45° field of view; without pupil dilation: 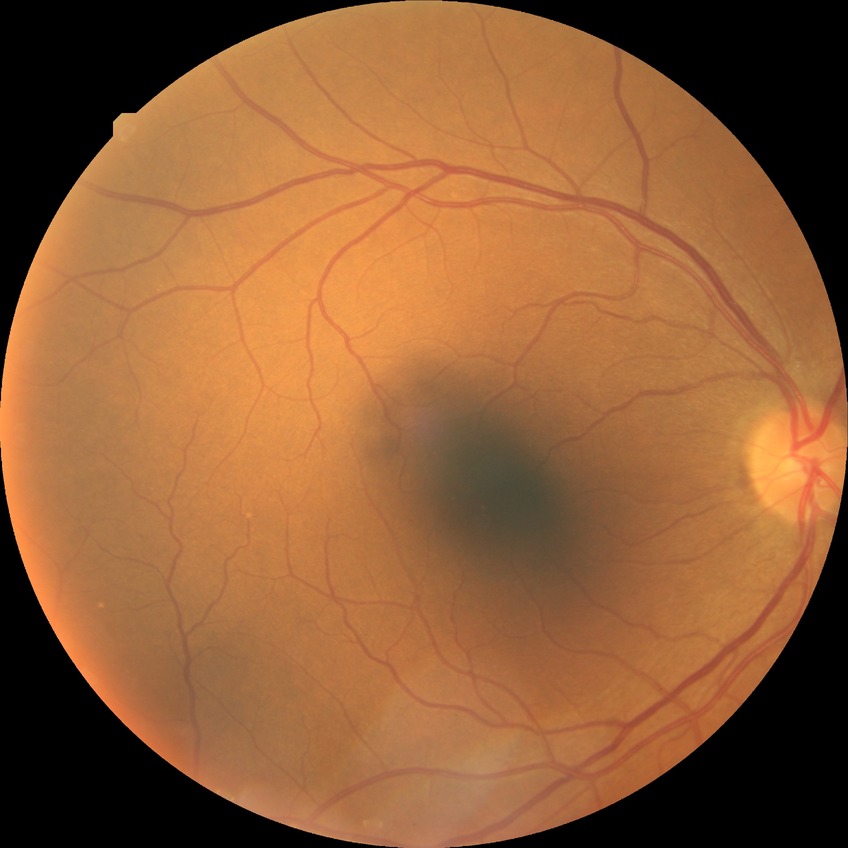 Modified Davis grade: NDR. No diabetic retinal disease findings.